848x848px. 45° field of view. Davis DR grading: 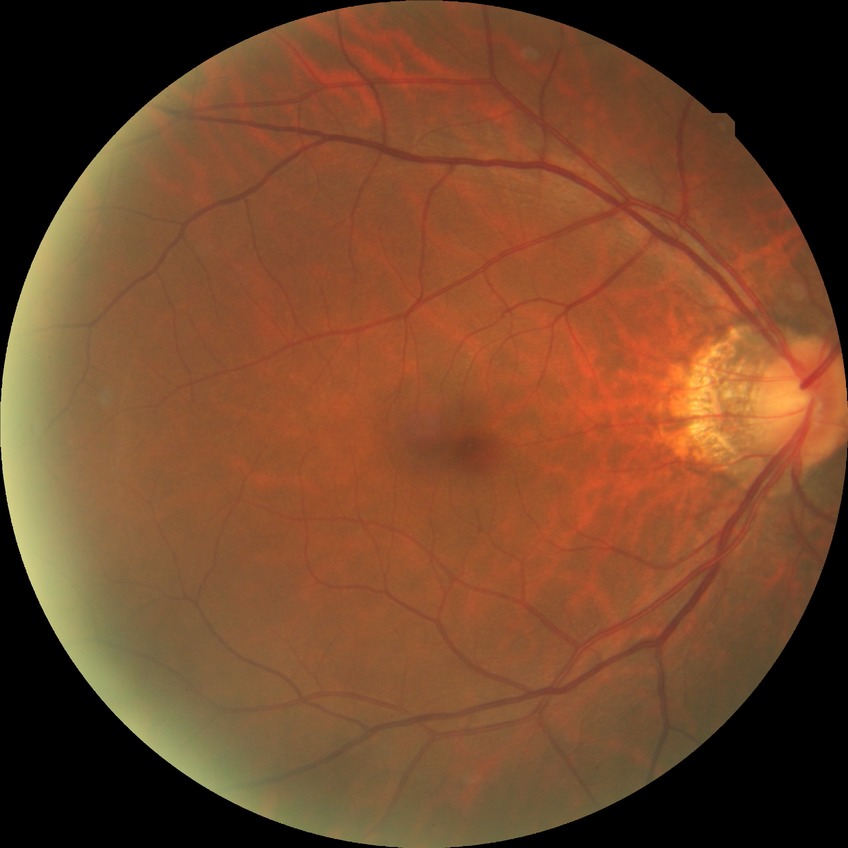   davis_grade: no diabetic retinopathy